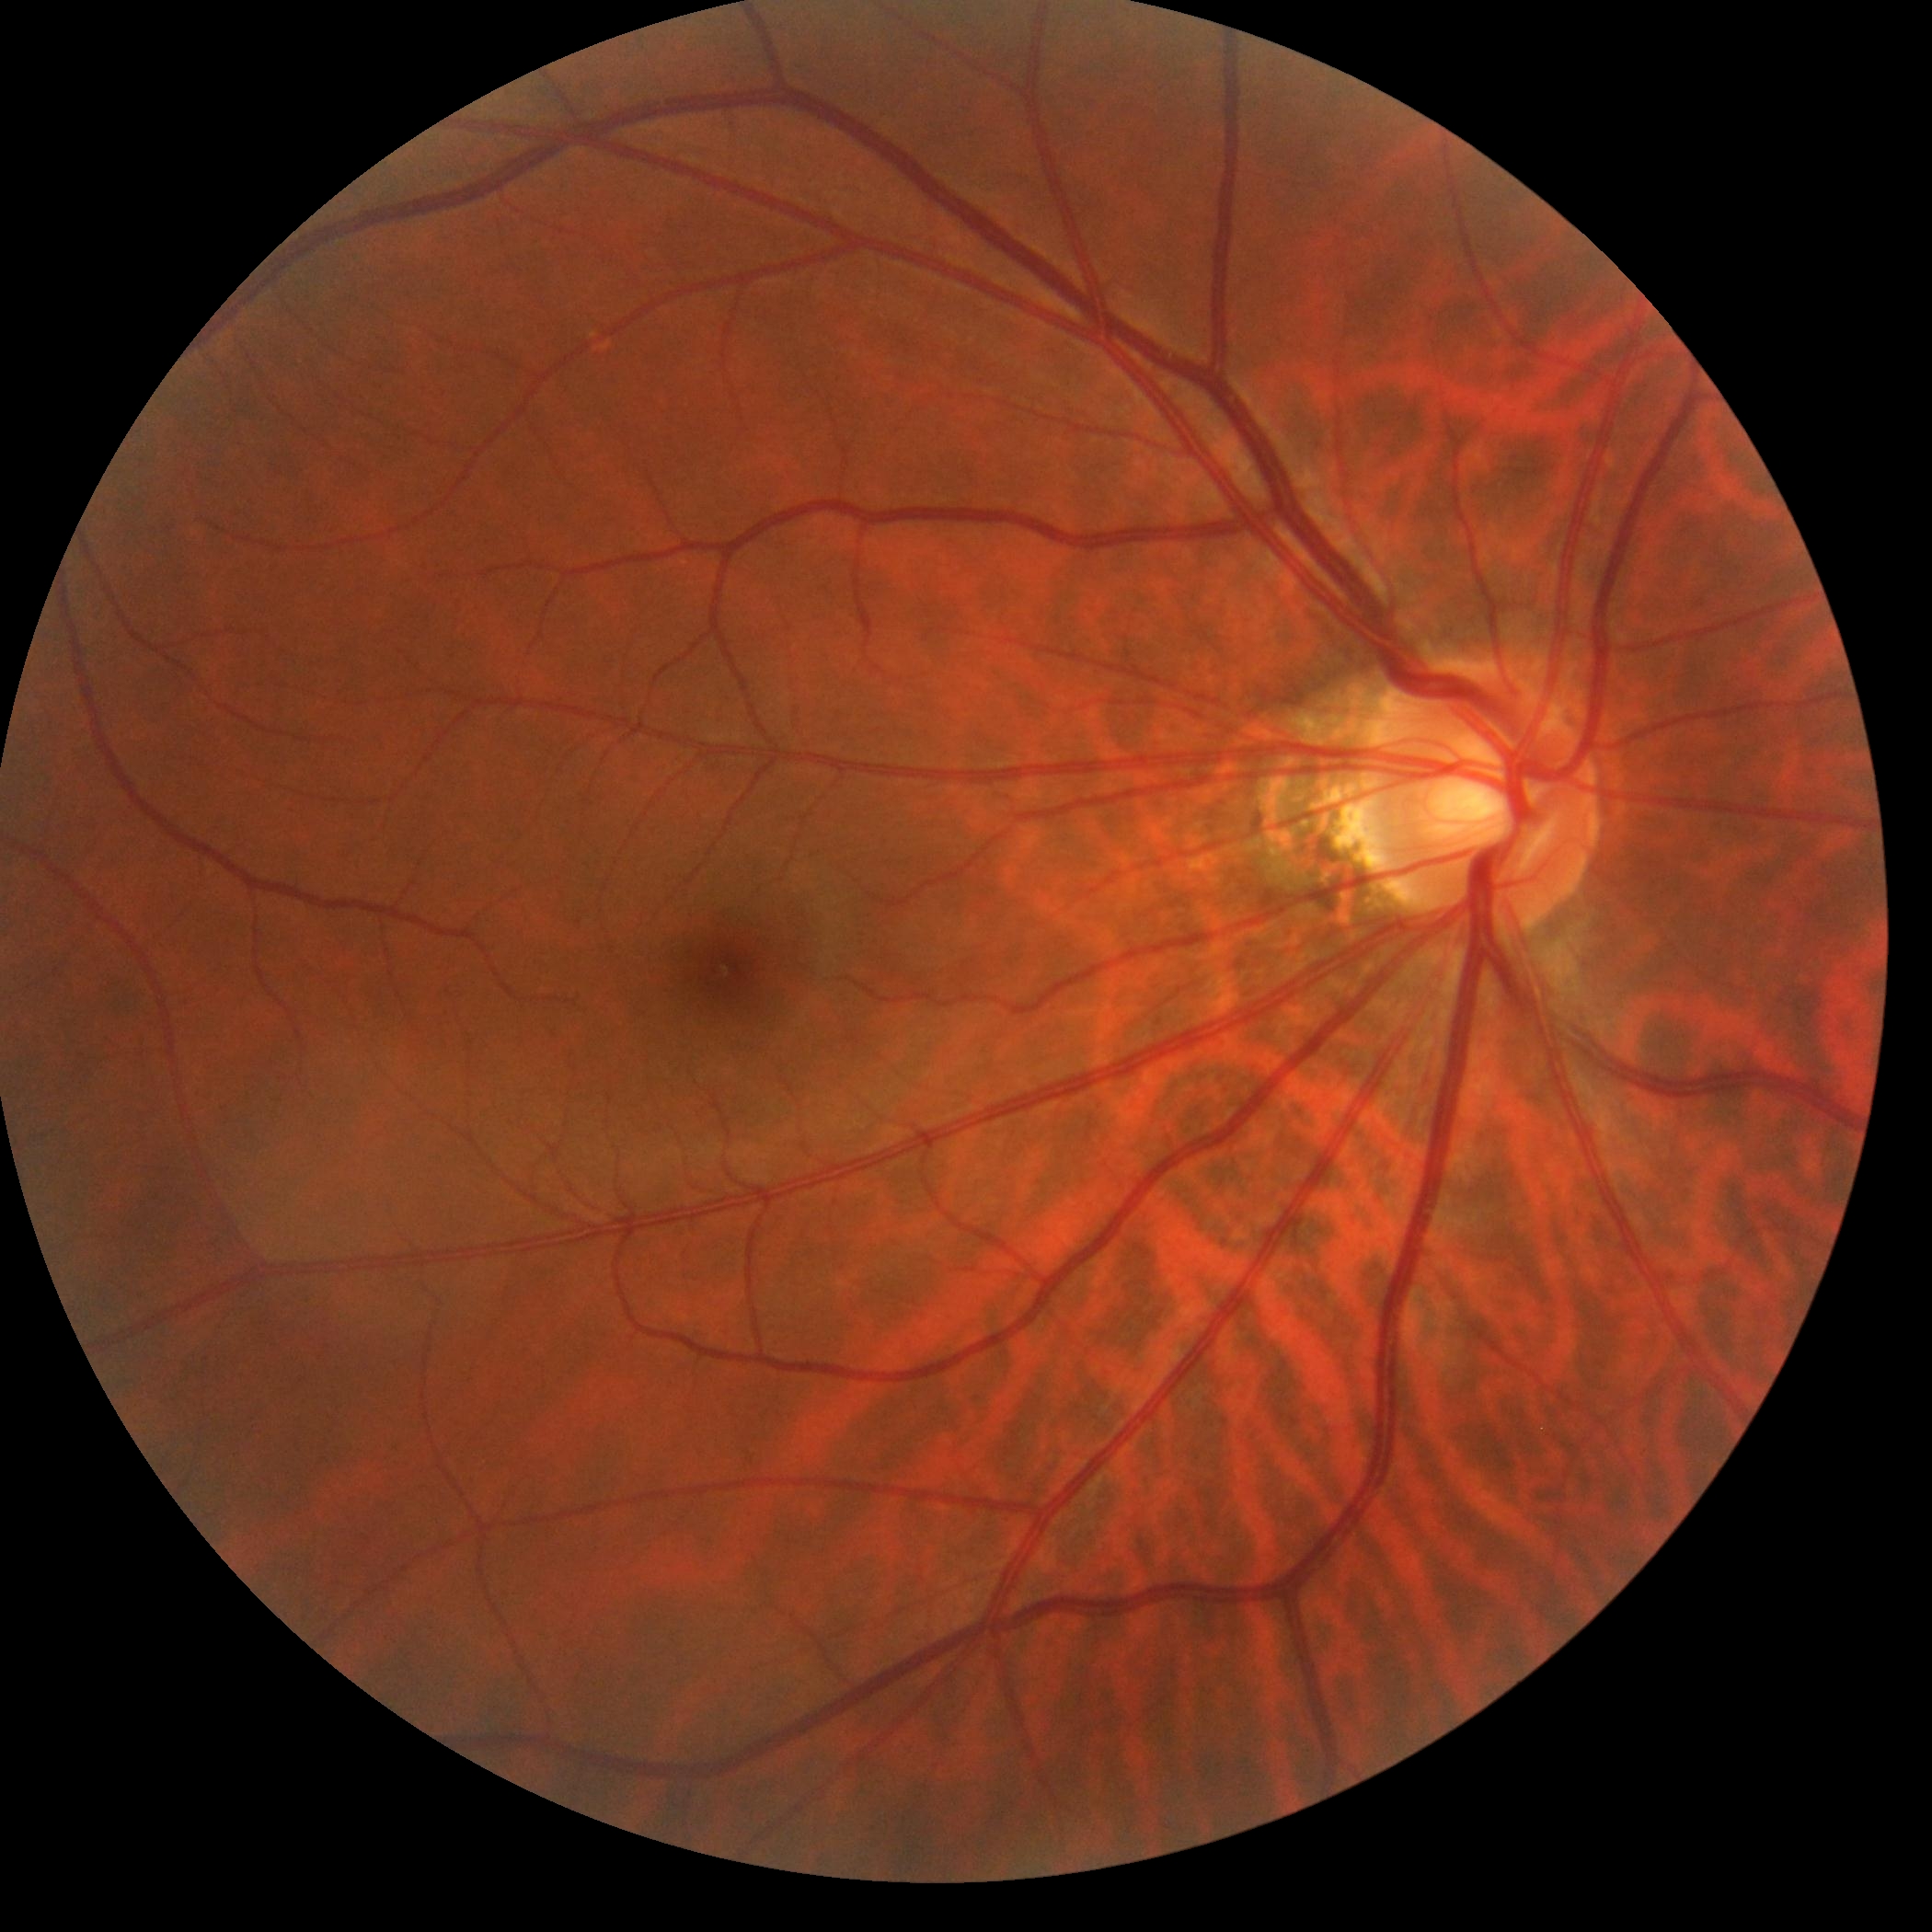
retinopathy=0/4, DR impression=negative for DR.